Fundus photo
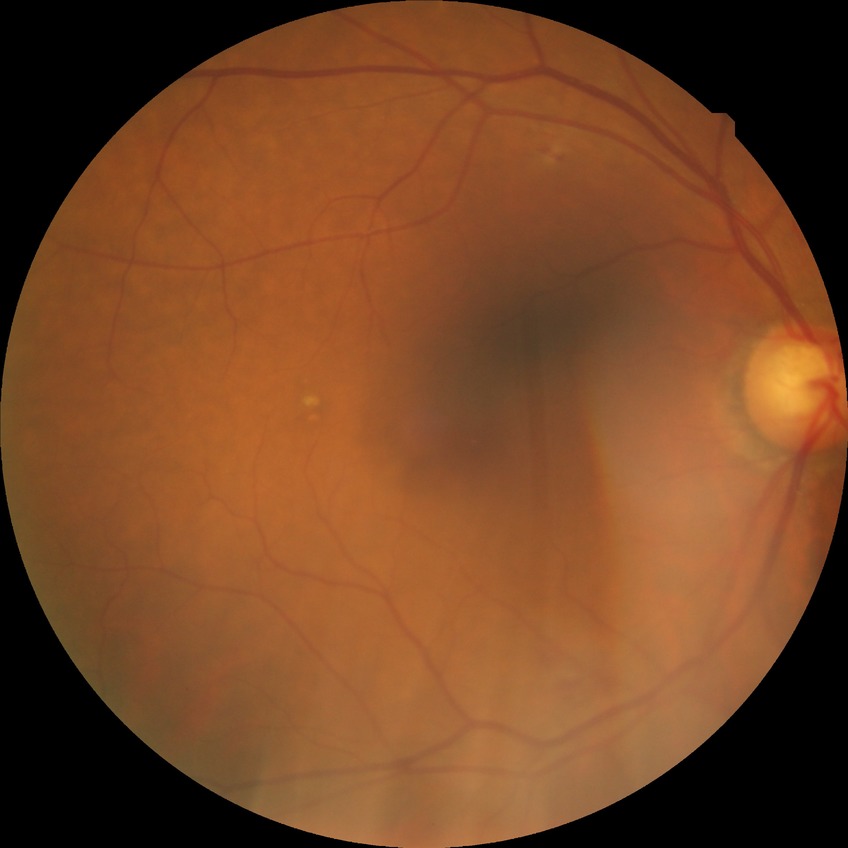 Diabetic retinopathy (DR) is simple diabetic retinopathy (SDR).